Modified Davis classification: 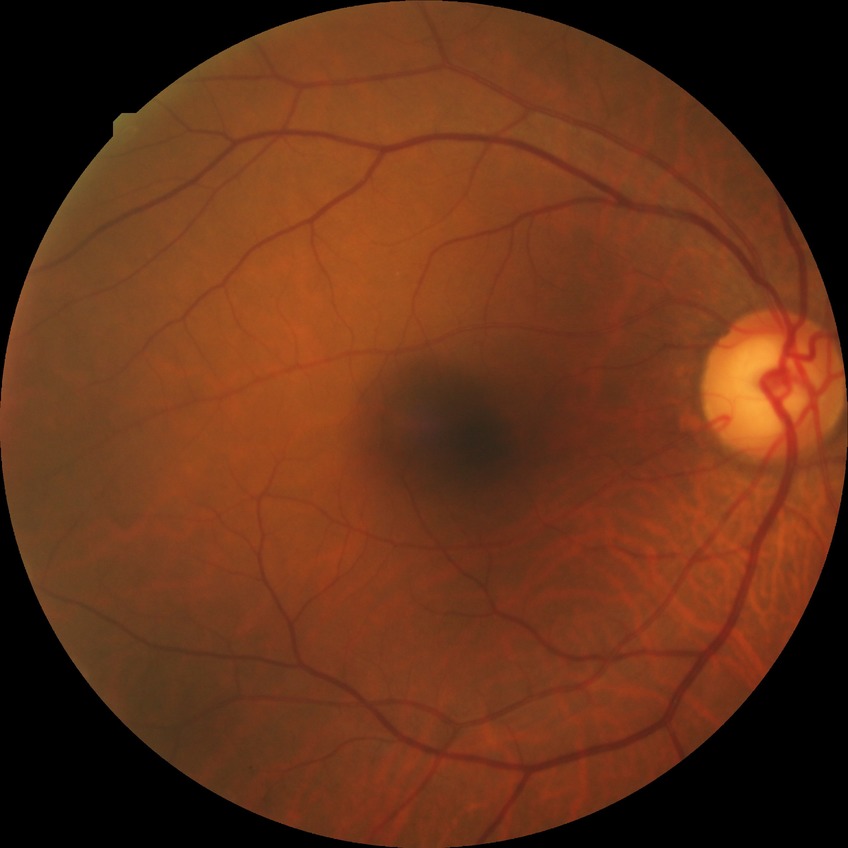 davis_grade: no diabetic retinopathy